1932 x 1932 pixels · mydriatic (tropicamide phenylephrine 1.0%) · Topcon TRC-NW8.
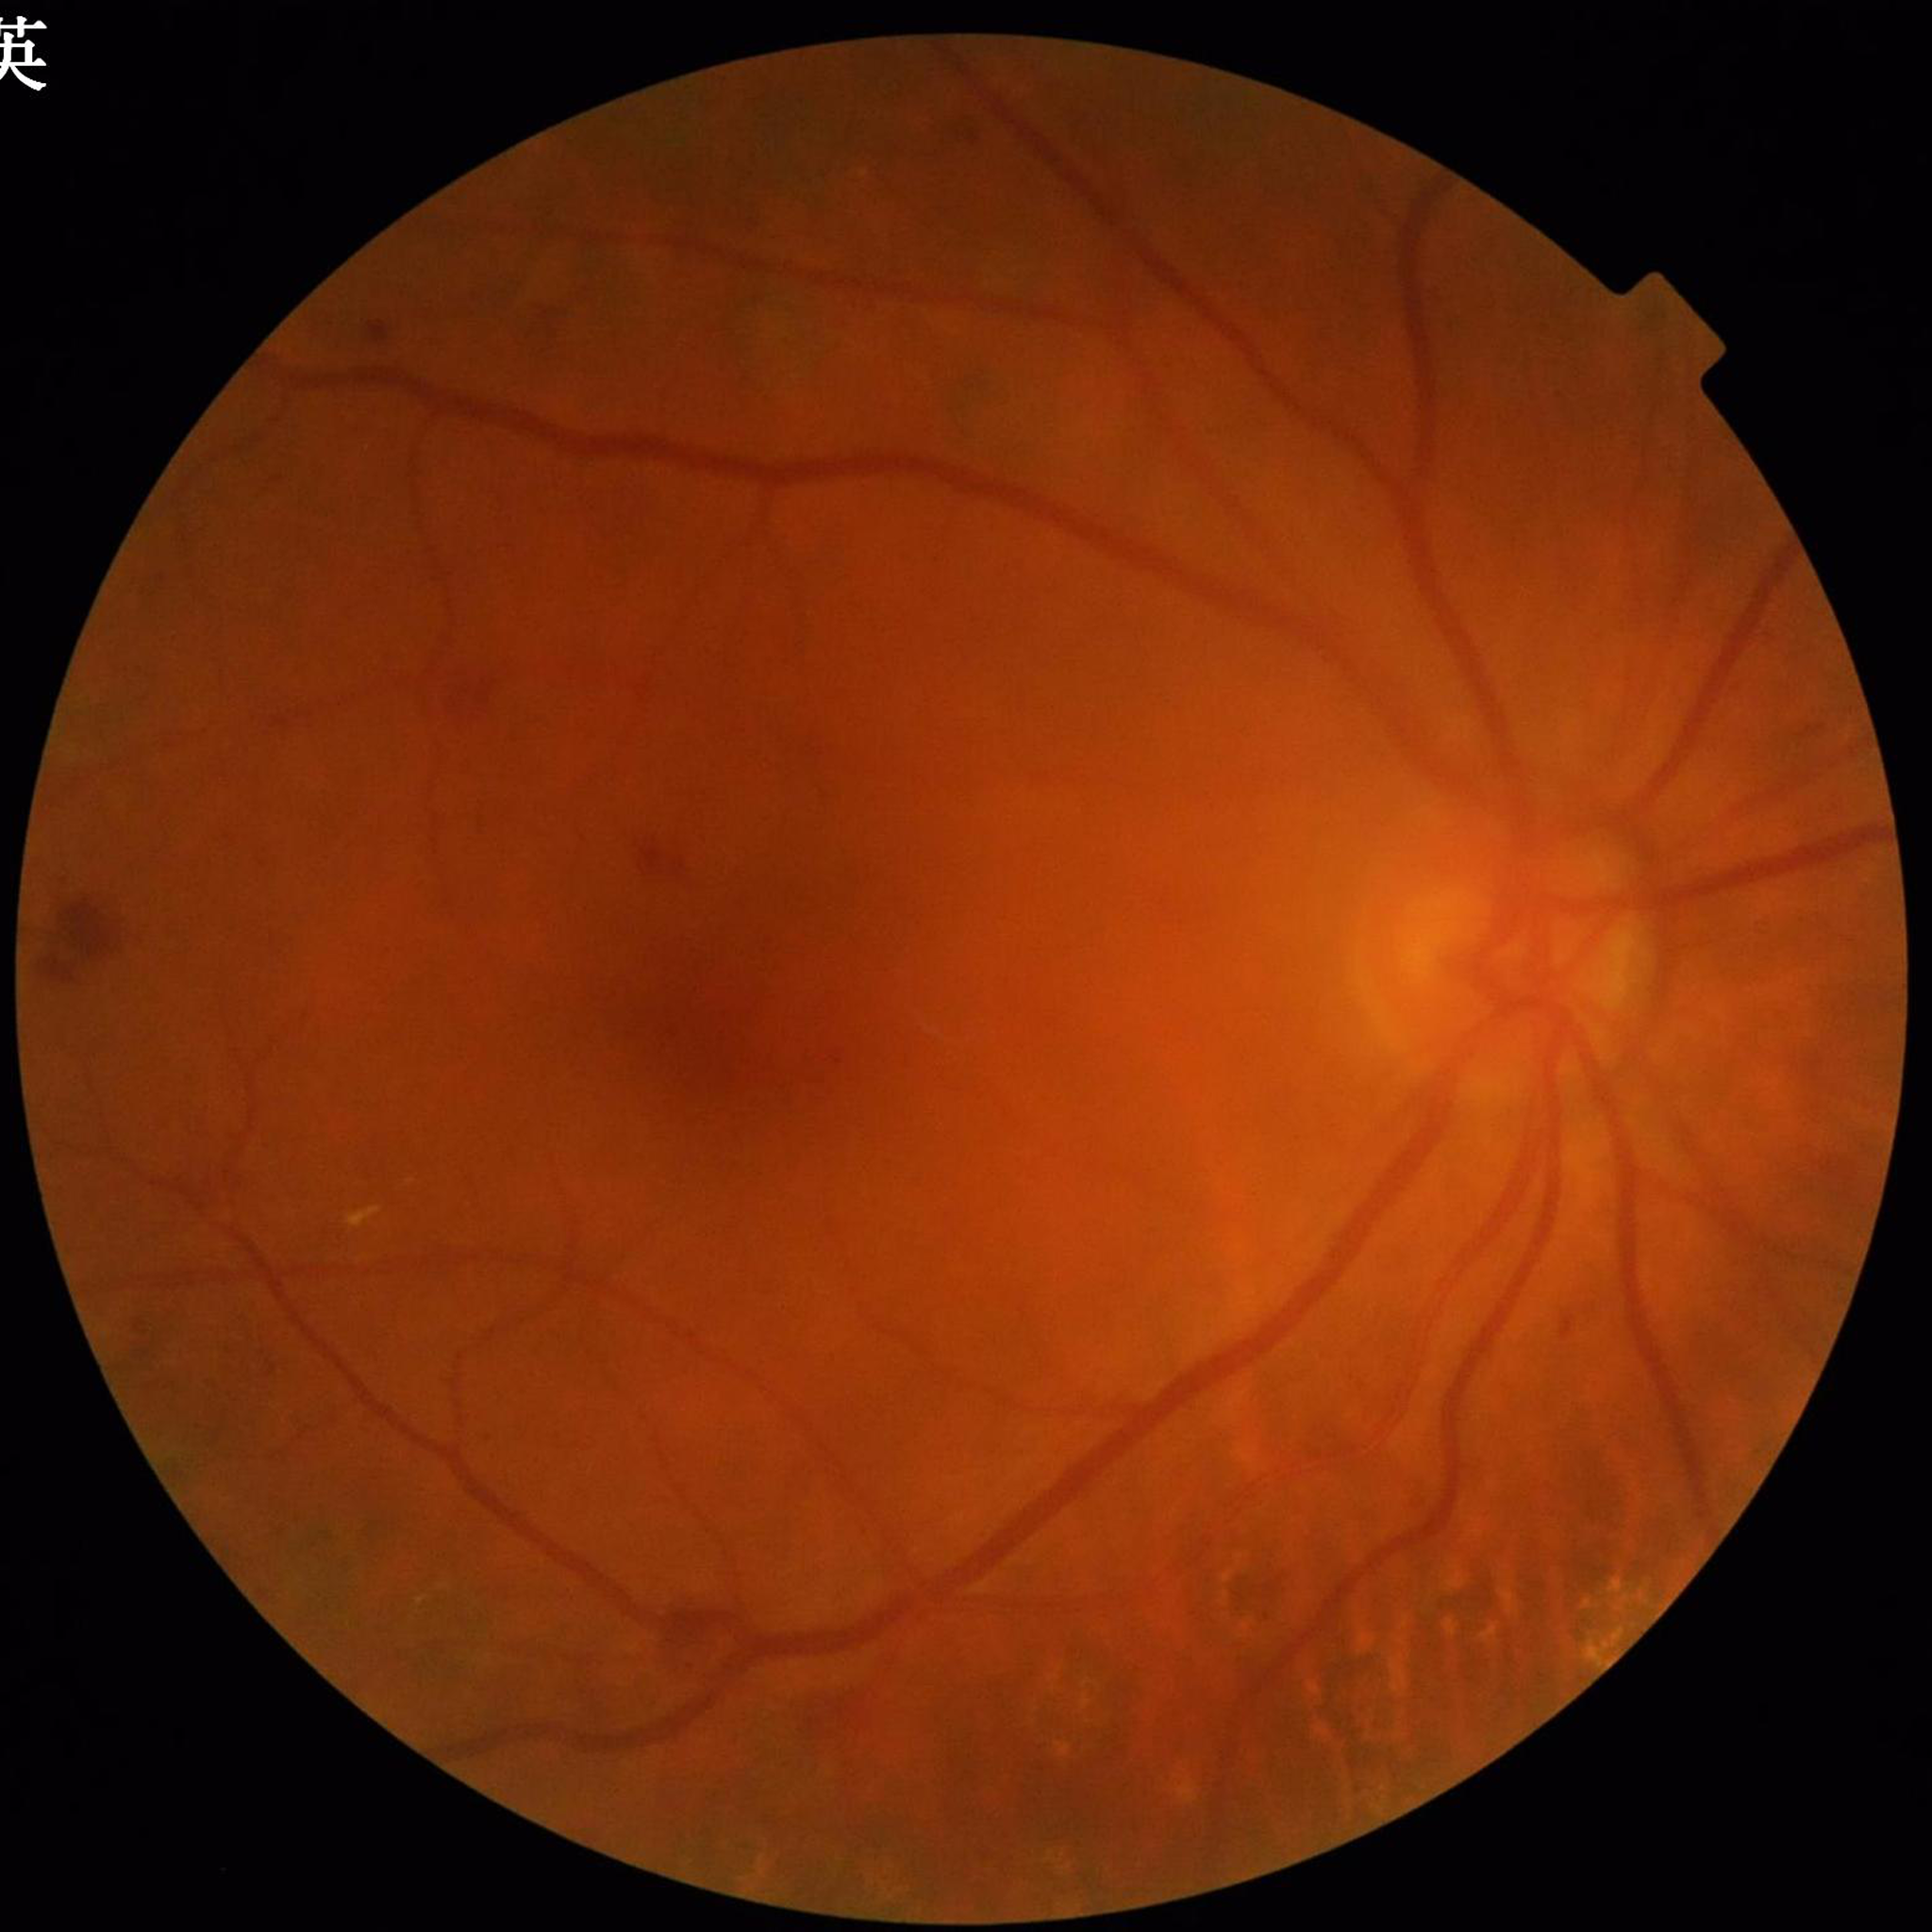

{
  "image_quality": "suboptimal — blur",
  "diagnosis": "diabetic retinopathy"
}